Color fundus image, field includes the optic disc and macula, 2228 x 1652 pixels:
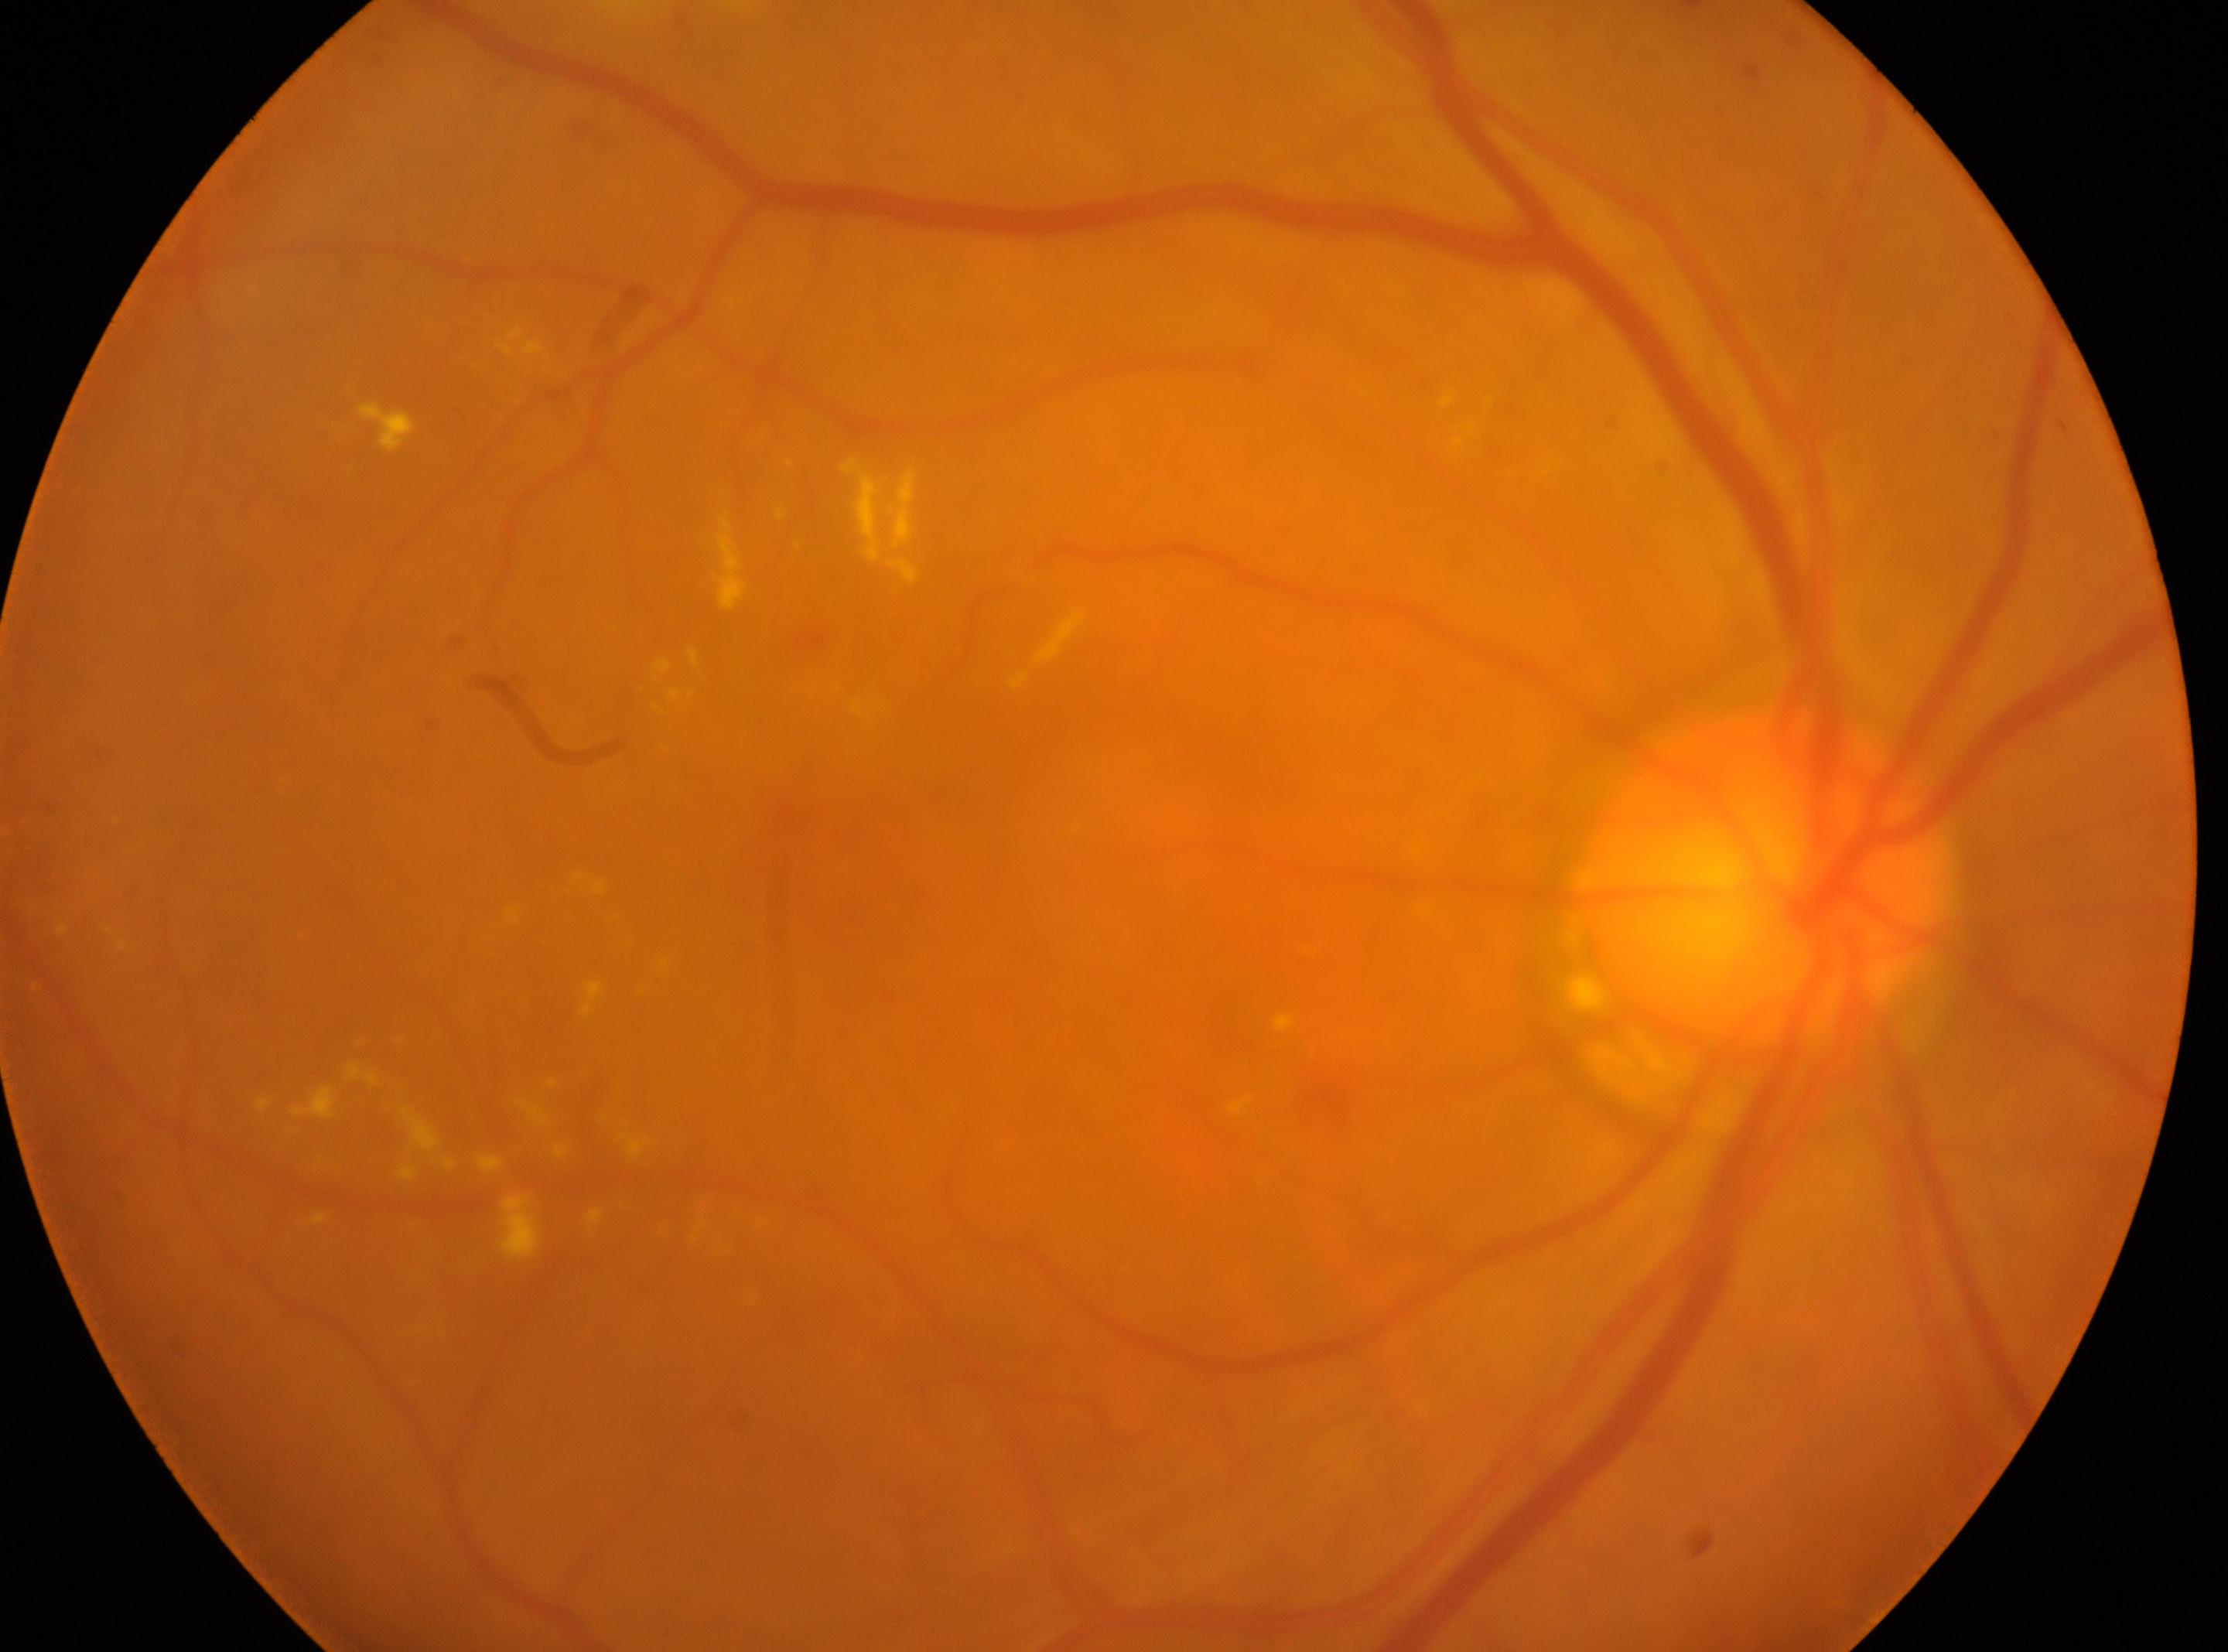

Eye: right.
DR stage is 2.
ONH located at x=1768, y=880.
Macula center: x=866, y=838.